CFP. 45° FOV: 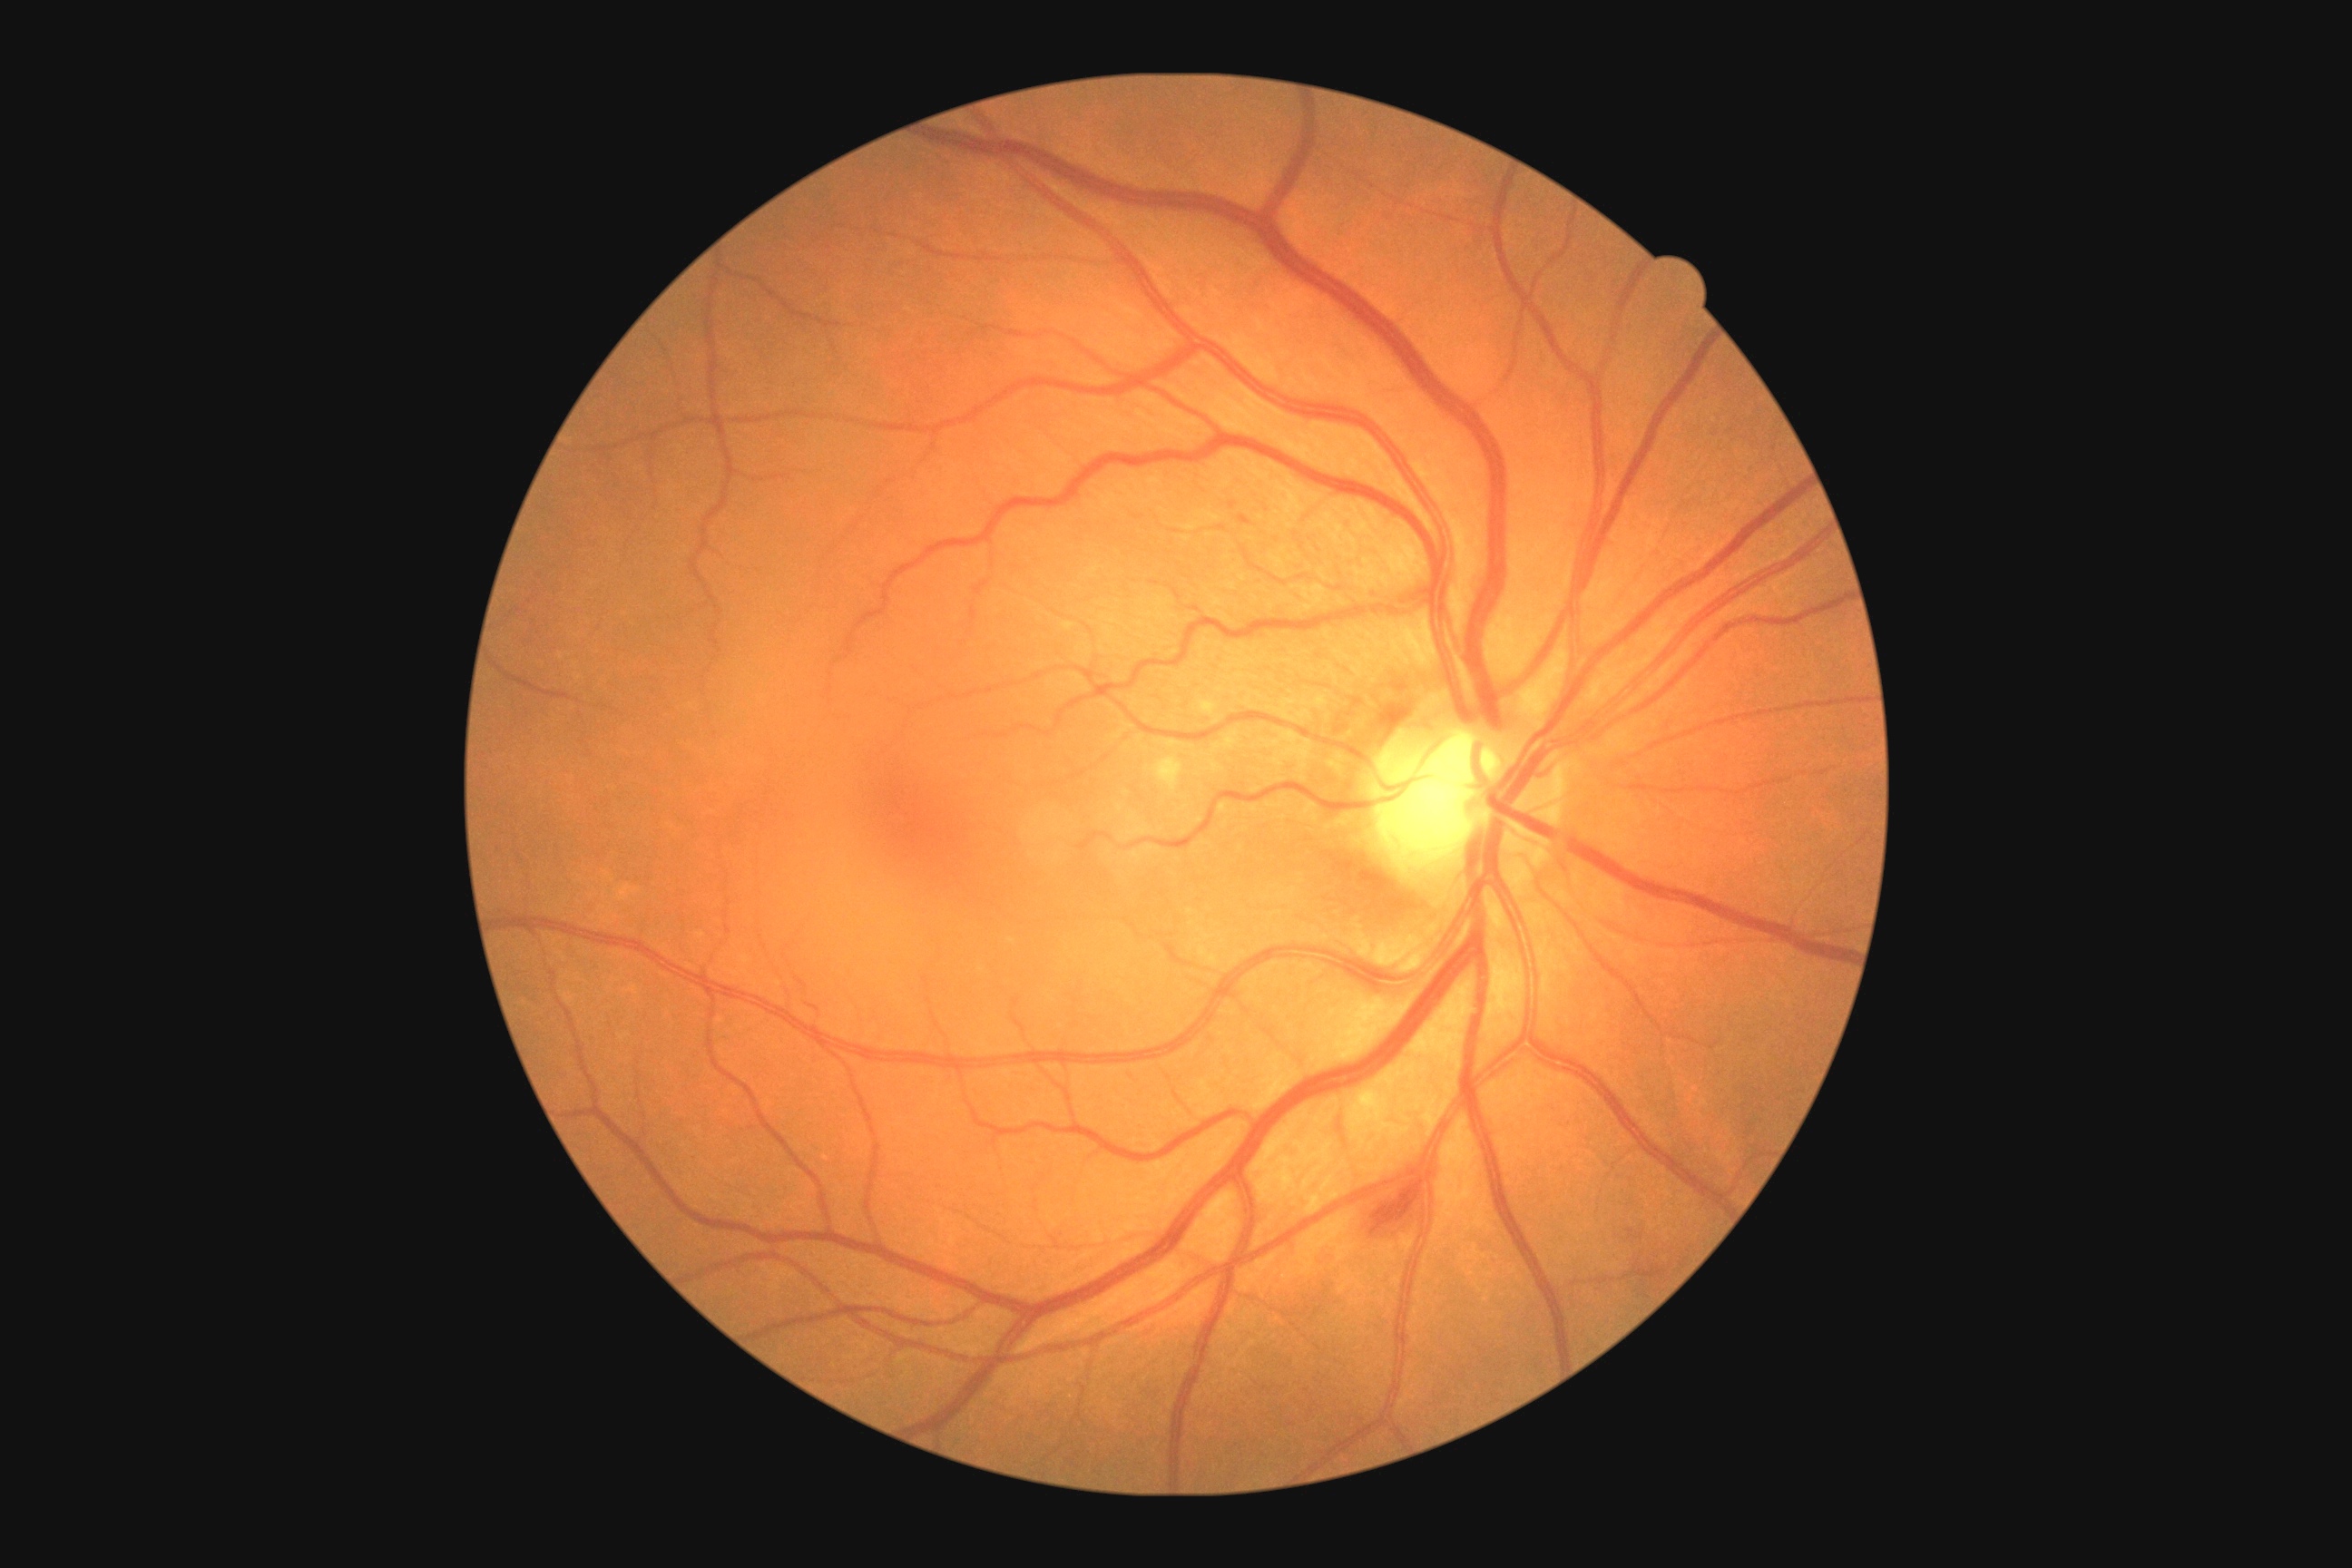
Annotations:
- DR severity — grade 2